640 x 480 pixels · wide-field fundus image from infant ROP screening.
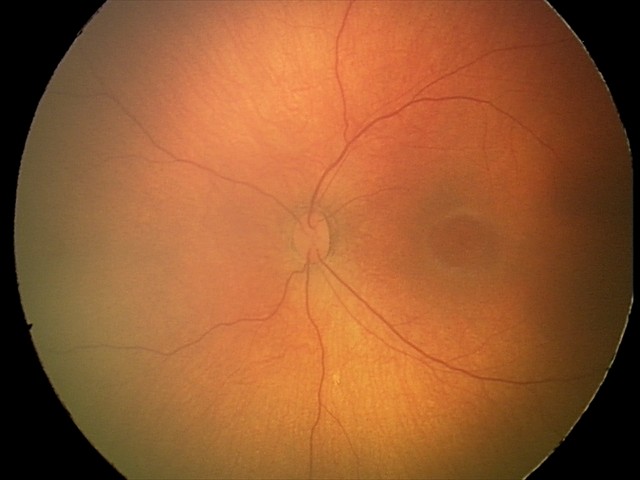
Impression: physiological finding.